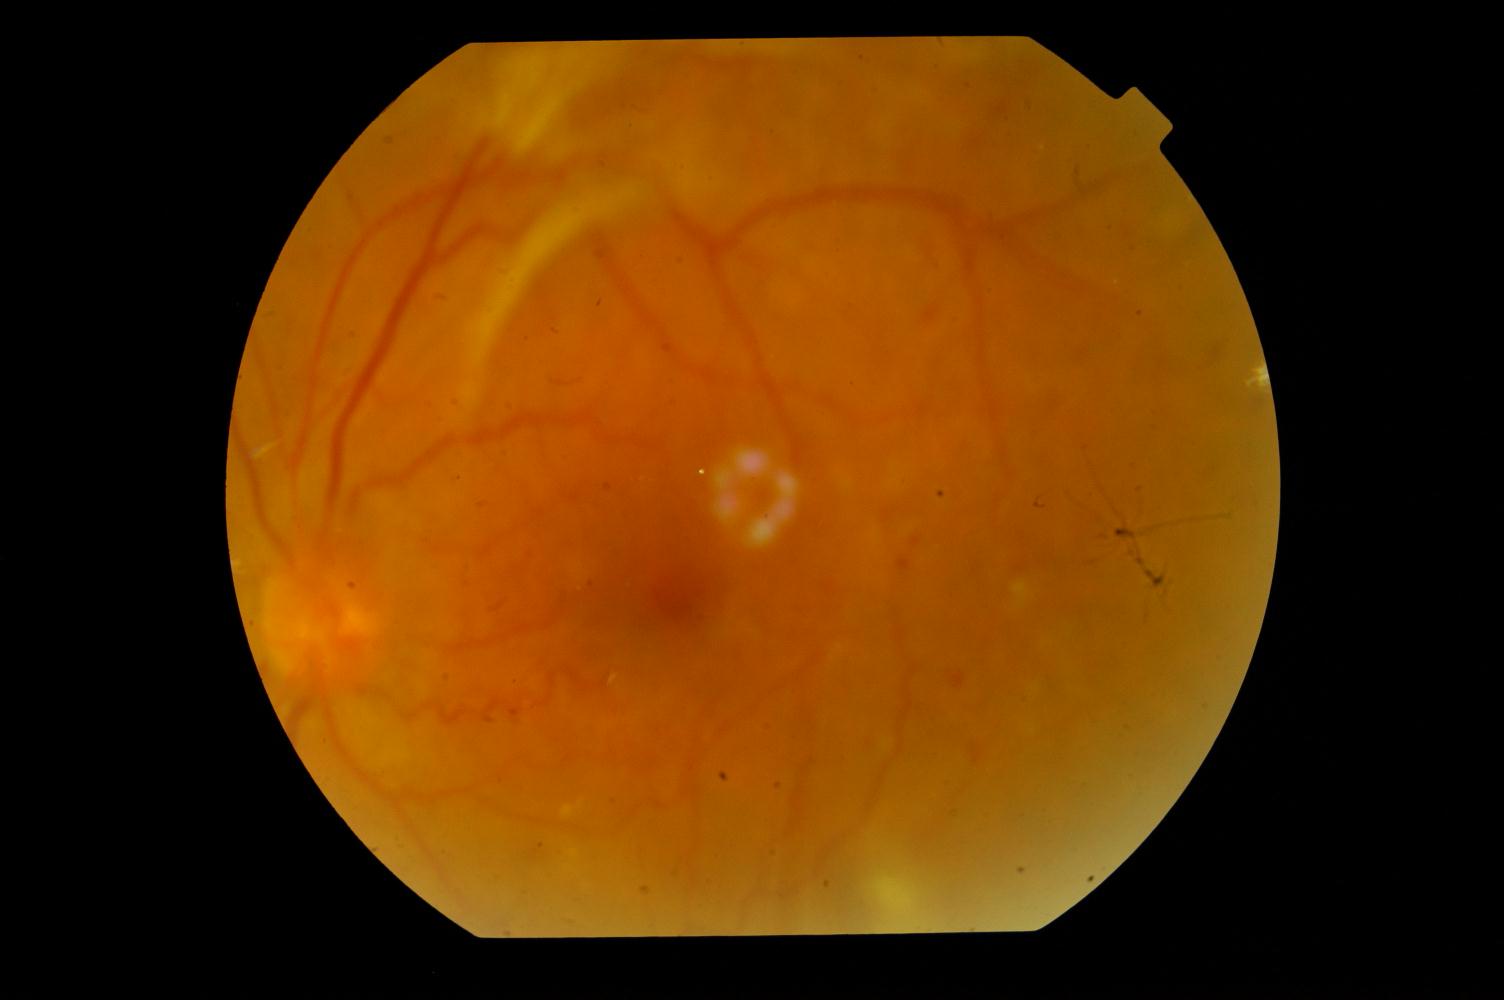 Diagnoses: DR (diabetic retinopathy).